45-degree field of view; modified Davis grading
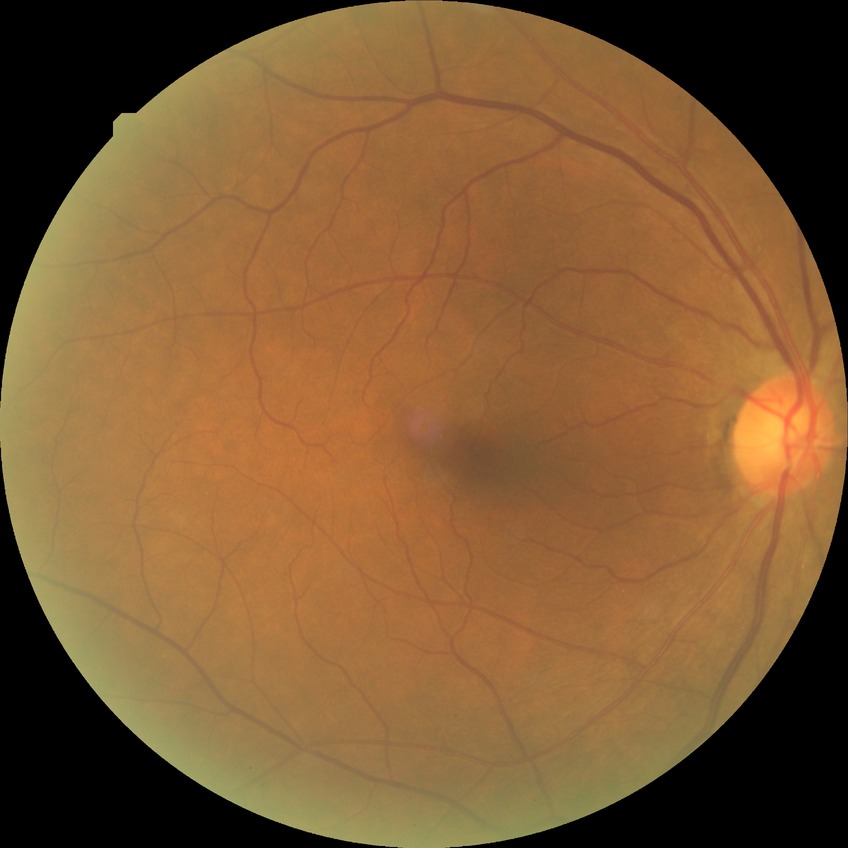
  davis_grade: no diabetic retinopathy